200° field of view, image size 1924x1556:
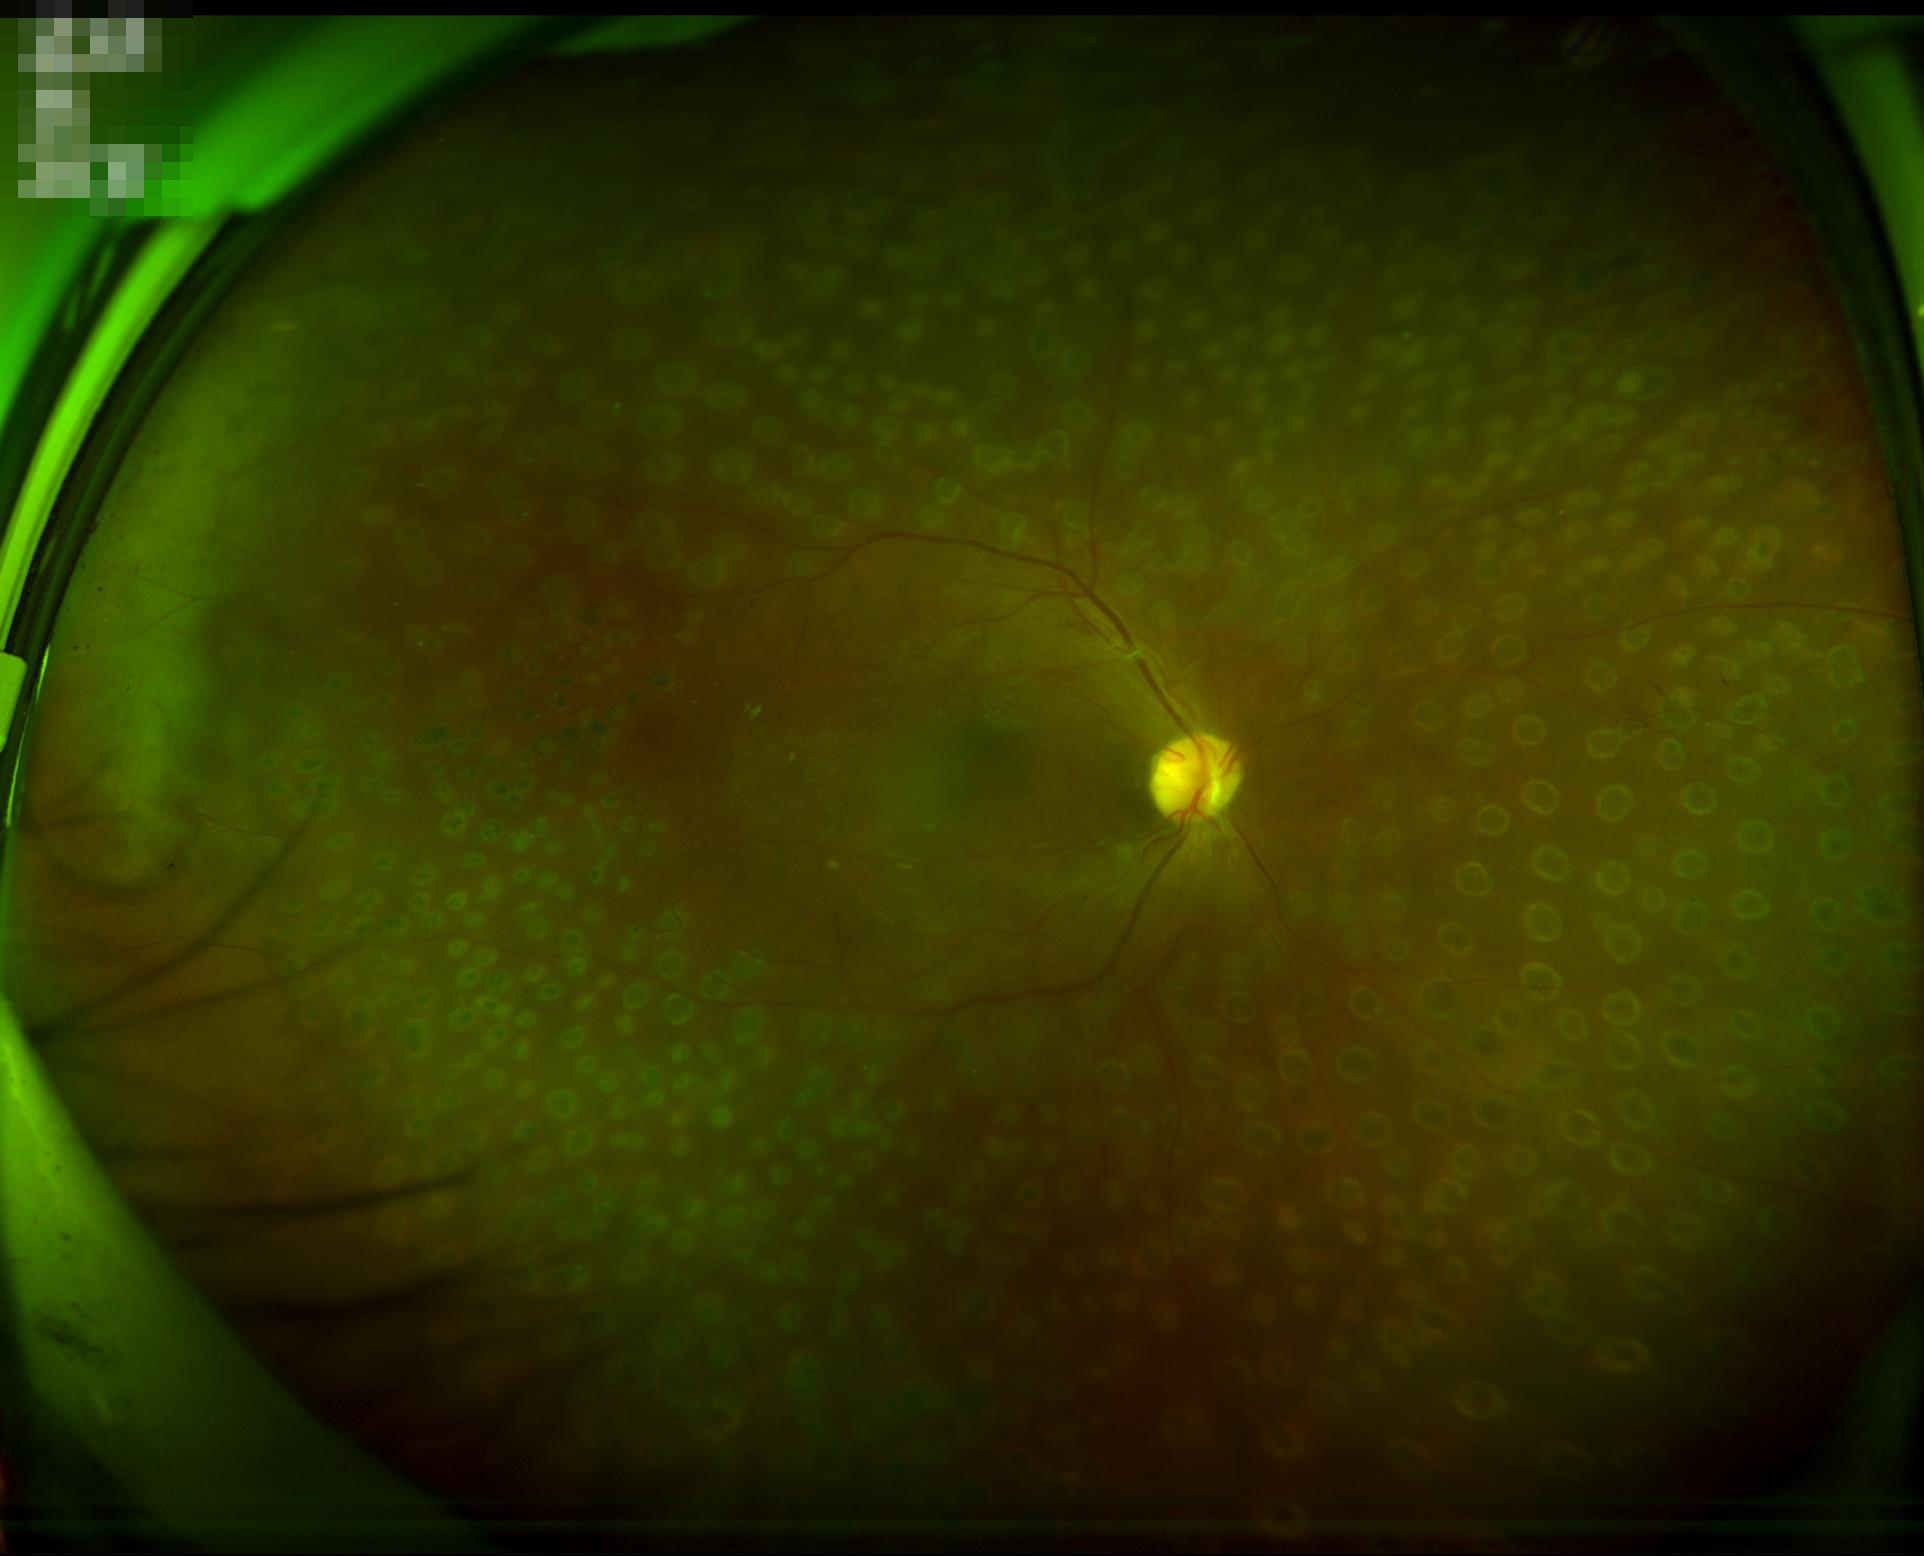

Adequate contrast for distinguishing structures.
Illumination is even.
Acceptable image quality.